Non-mydriatic — 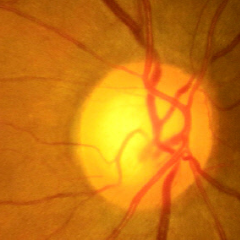

Assessment: no signs of glaucoma.